Color fundus image.
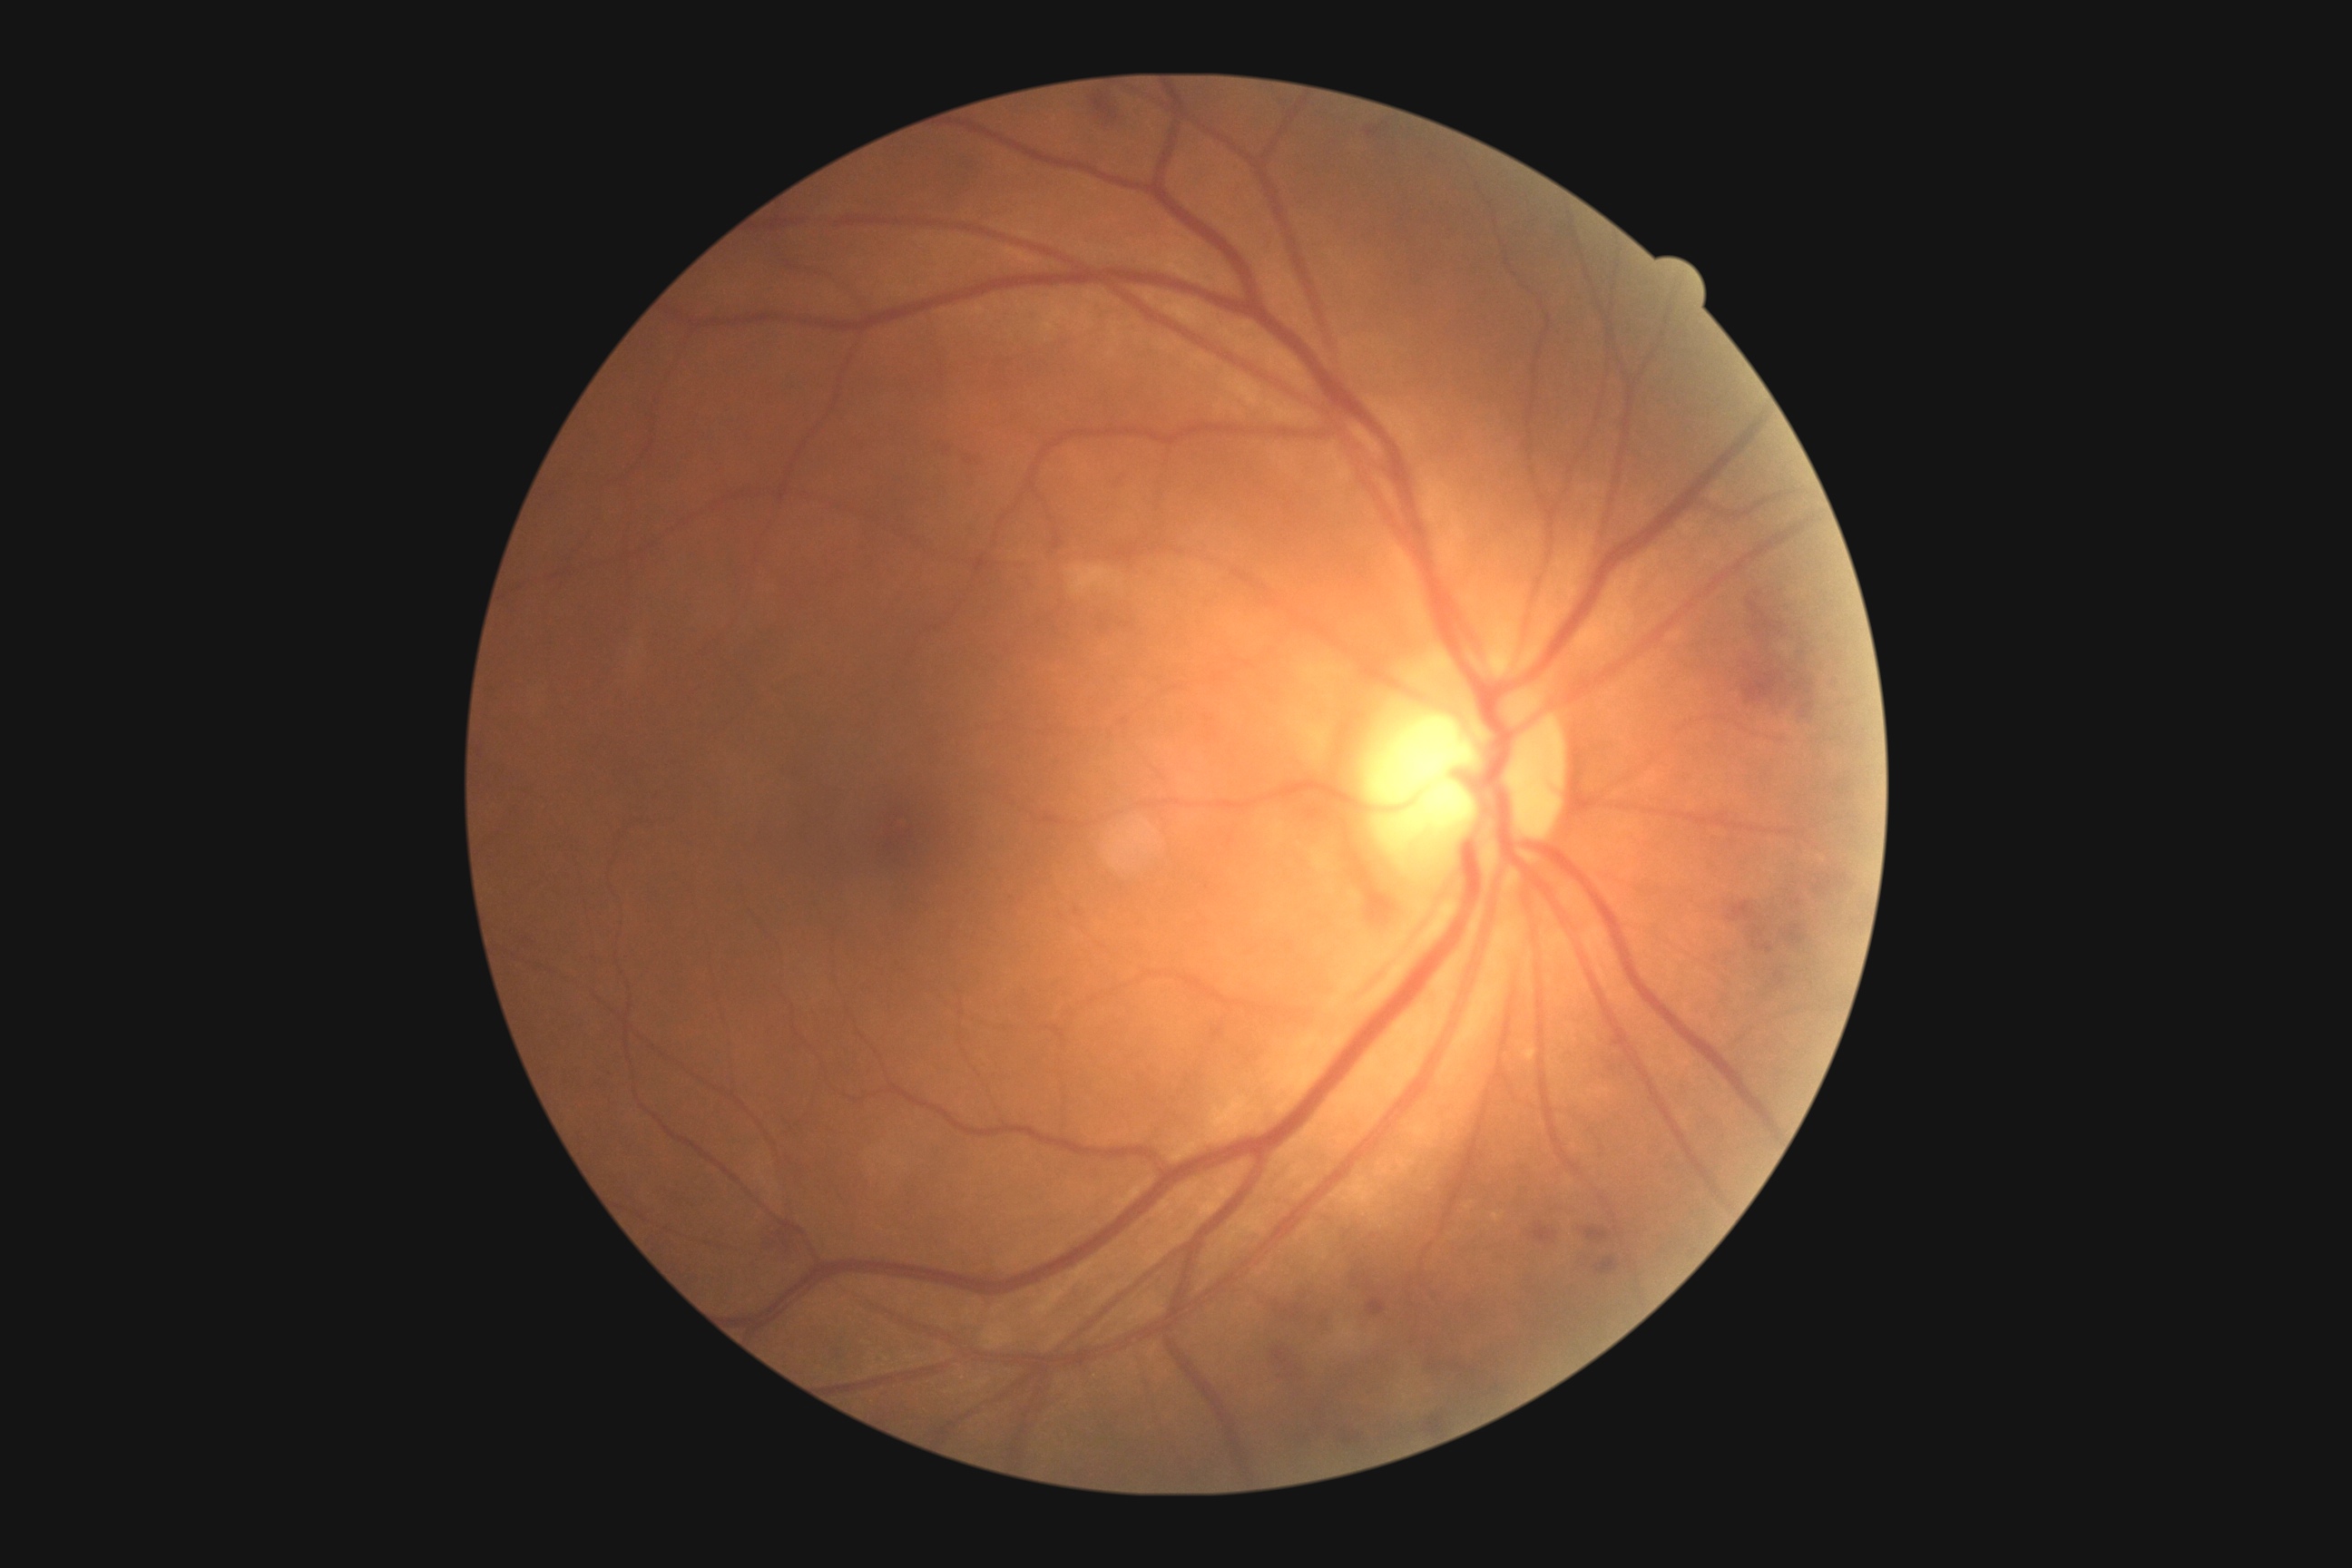

Findings:
- diabetic retinopathy grade: 2
- DR class: non-proliferative diabetic retinopathy